Captured on a Nidek AFC-330 fundus camera; non-mydriatic acquisition:
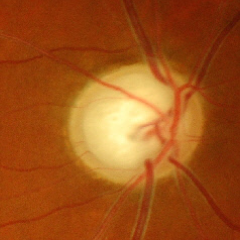 The image shows advanced glaucoma.